Wide-field contact fundus photograph of an infant: 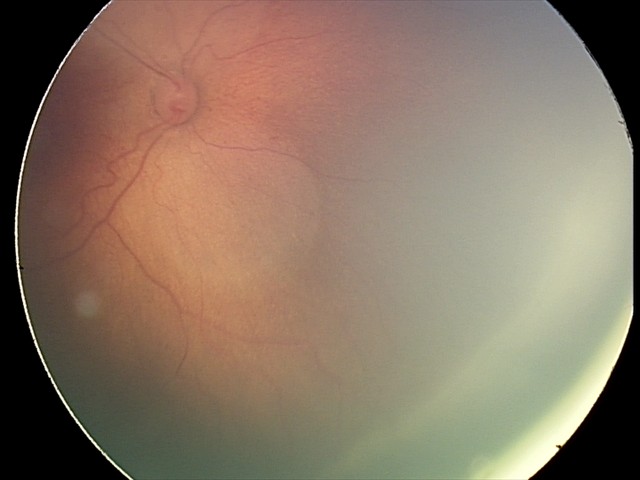 Without plus disease.
Examination diagnosed as ROP stage 2.